Color fundus photograph · 1923 by 1932 pixels · 45-degree field of view.
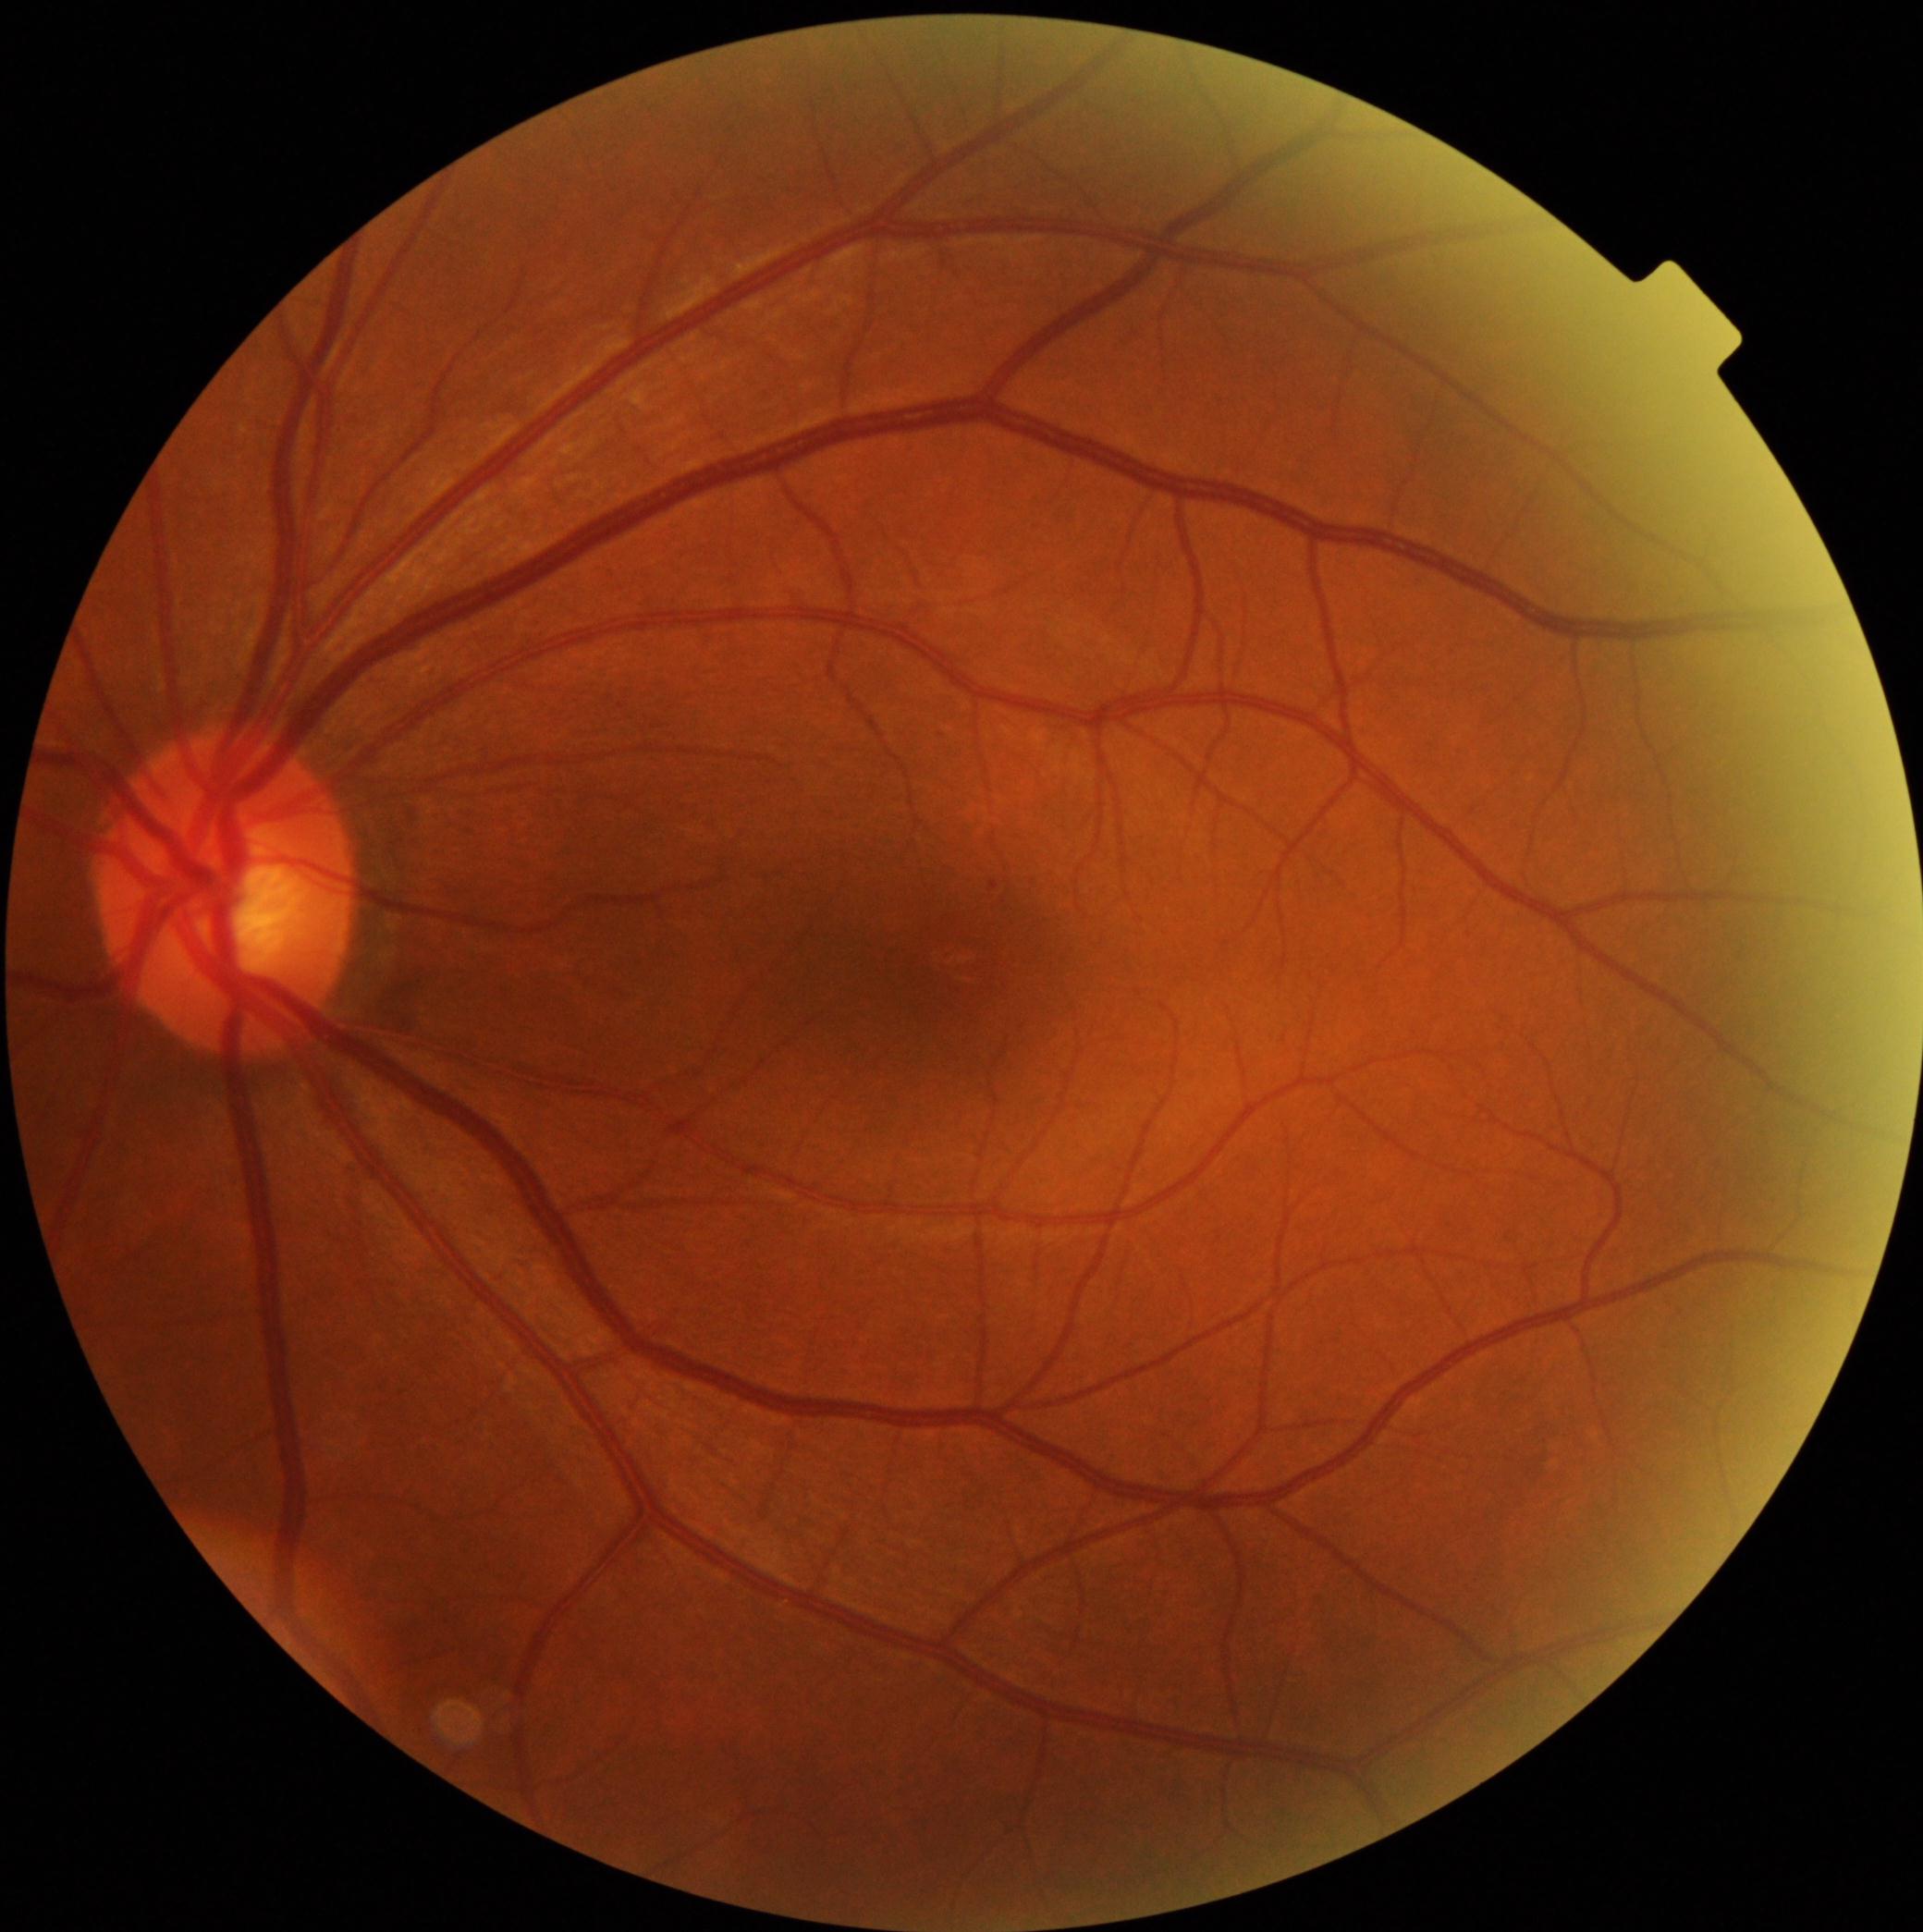

DR: grade 1.